2089x1764, color fundus photograph
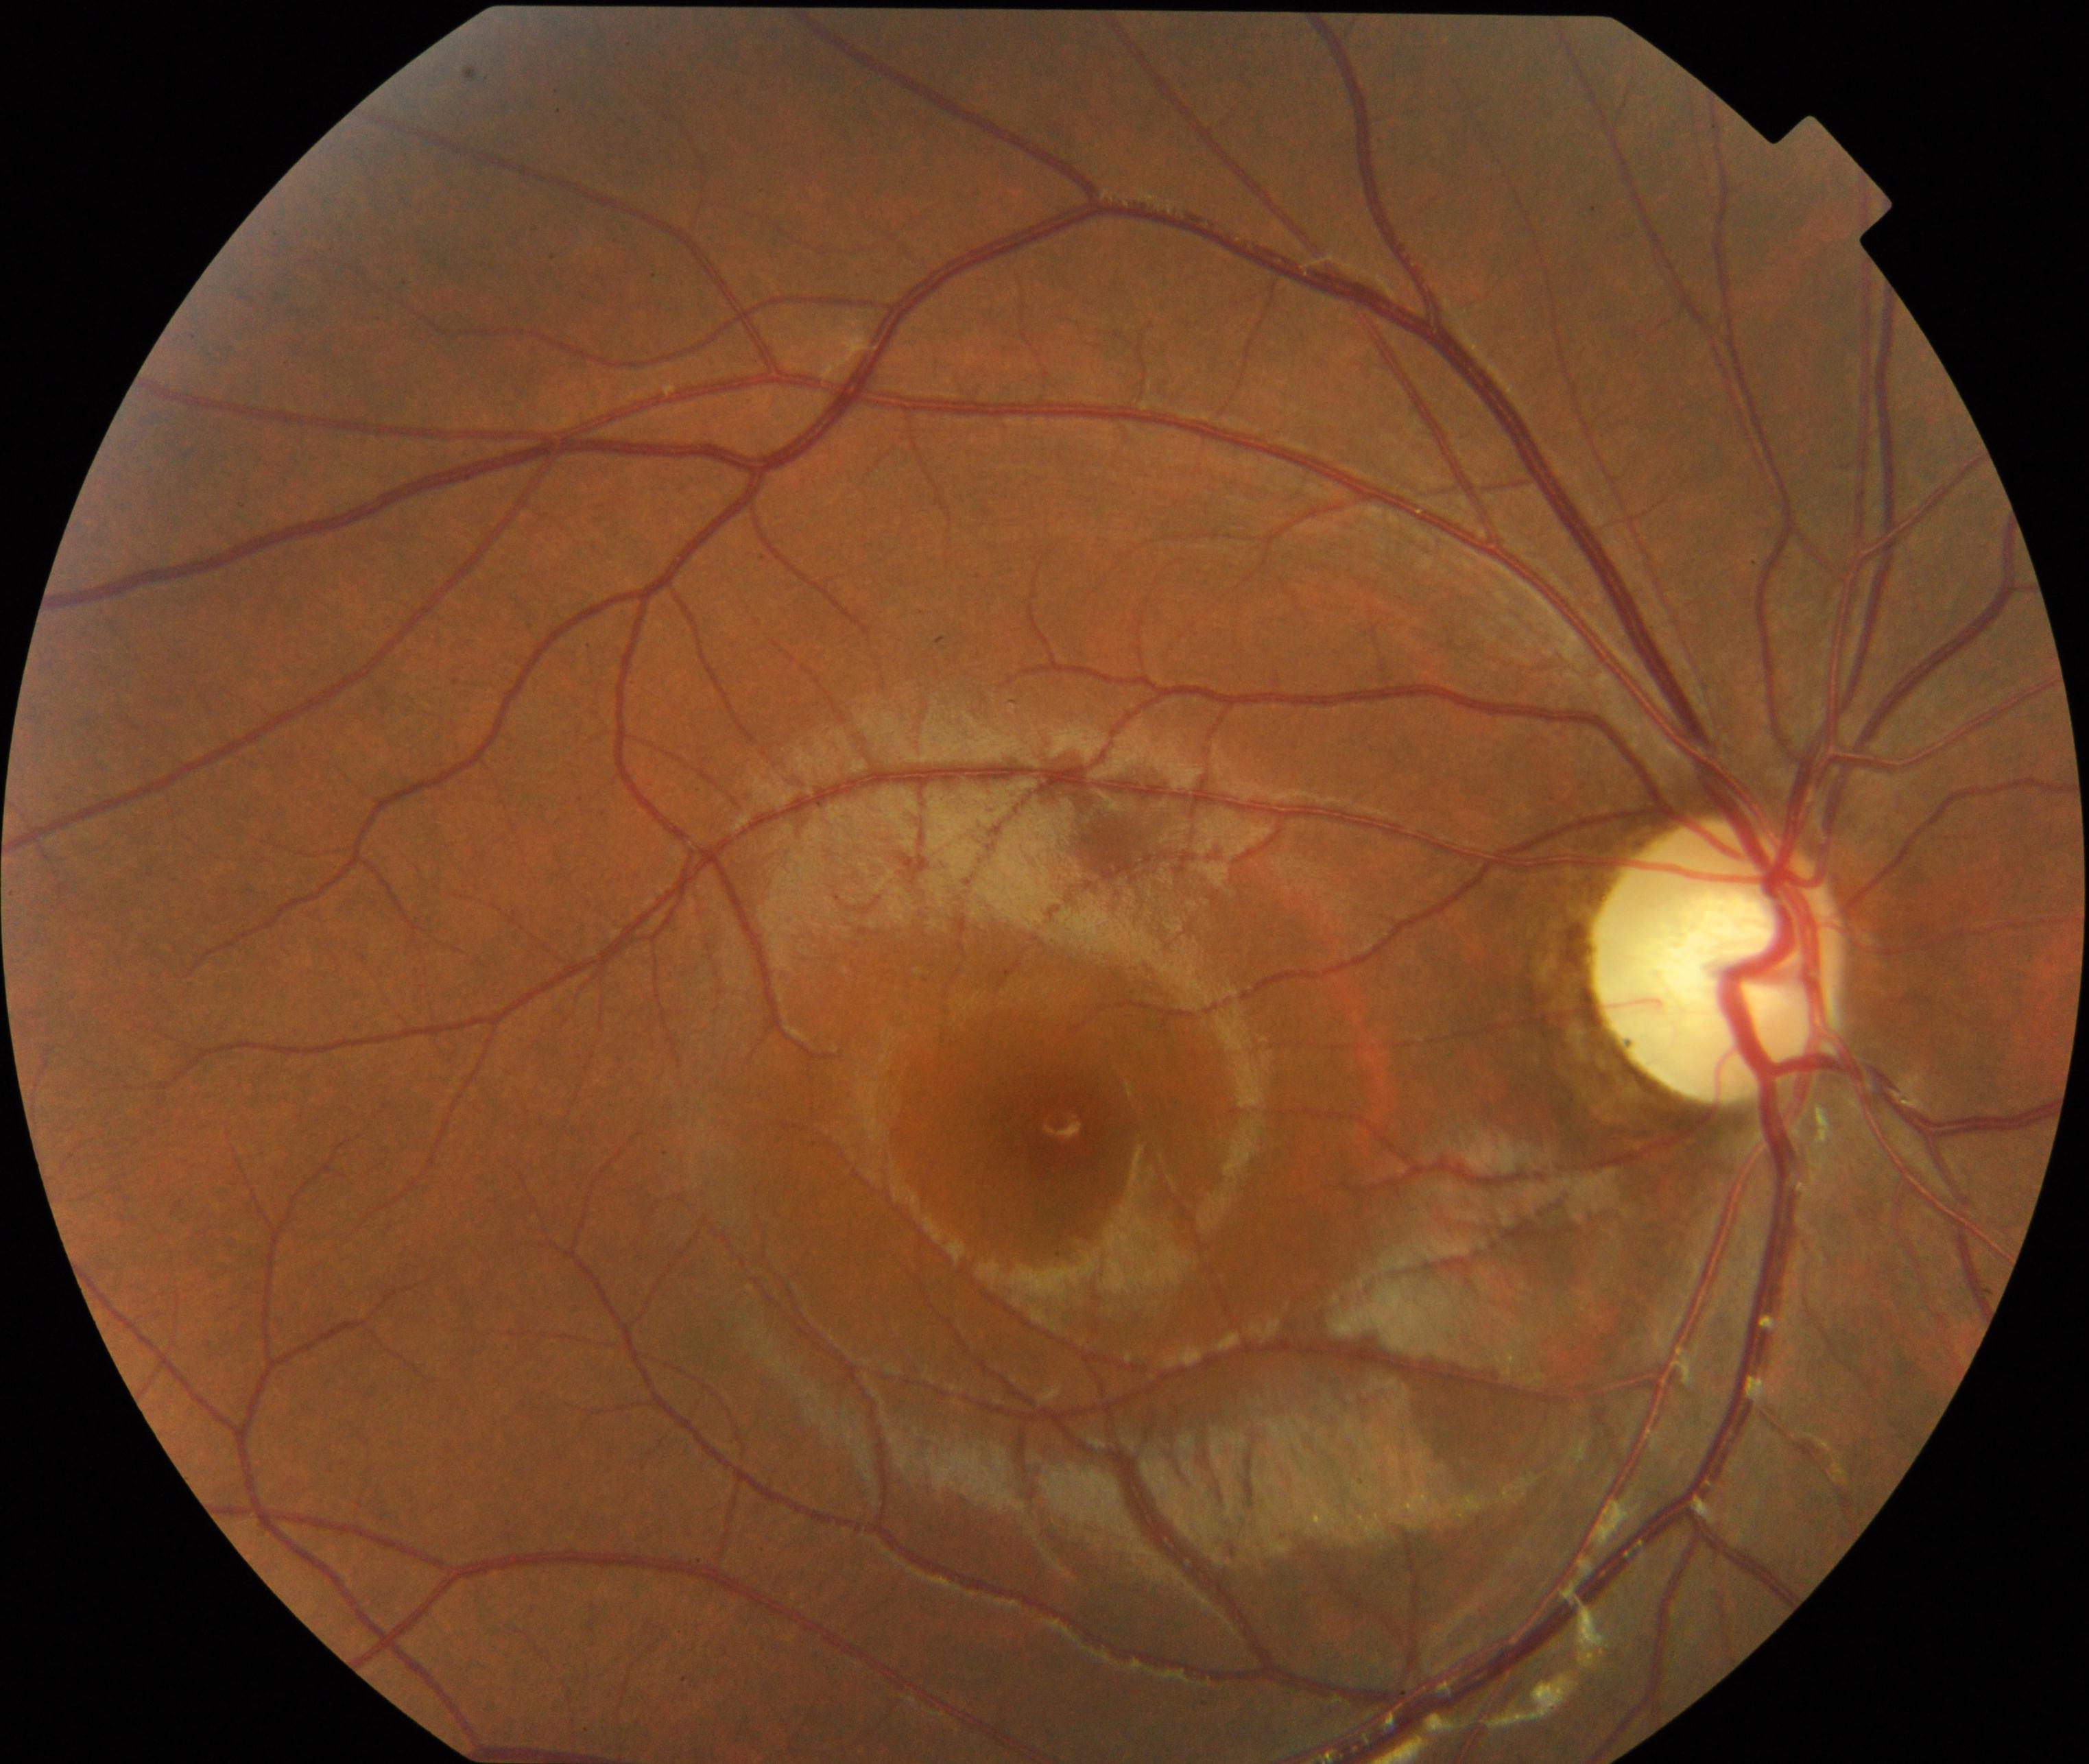
Appearance consistent with optic atrophy. Defined by white optic disc with reduced small vessels on the disc, attenuation of peripapillary vessels, and thinning of the retinal nerve fiber layer, sometimes with Paton lines.